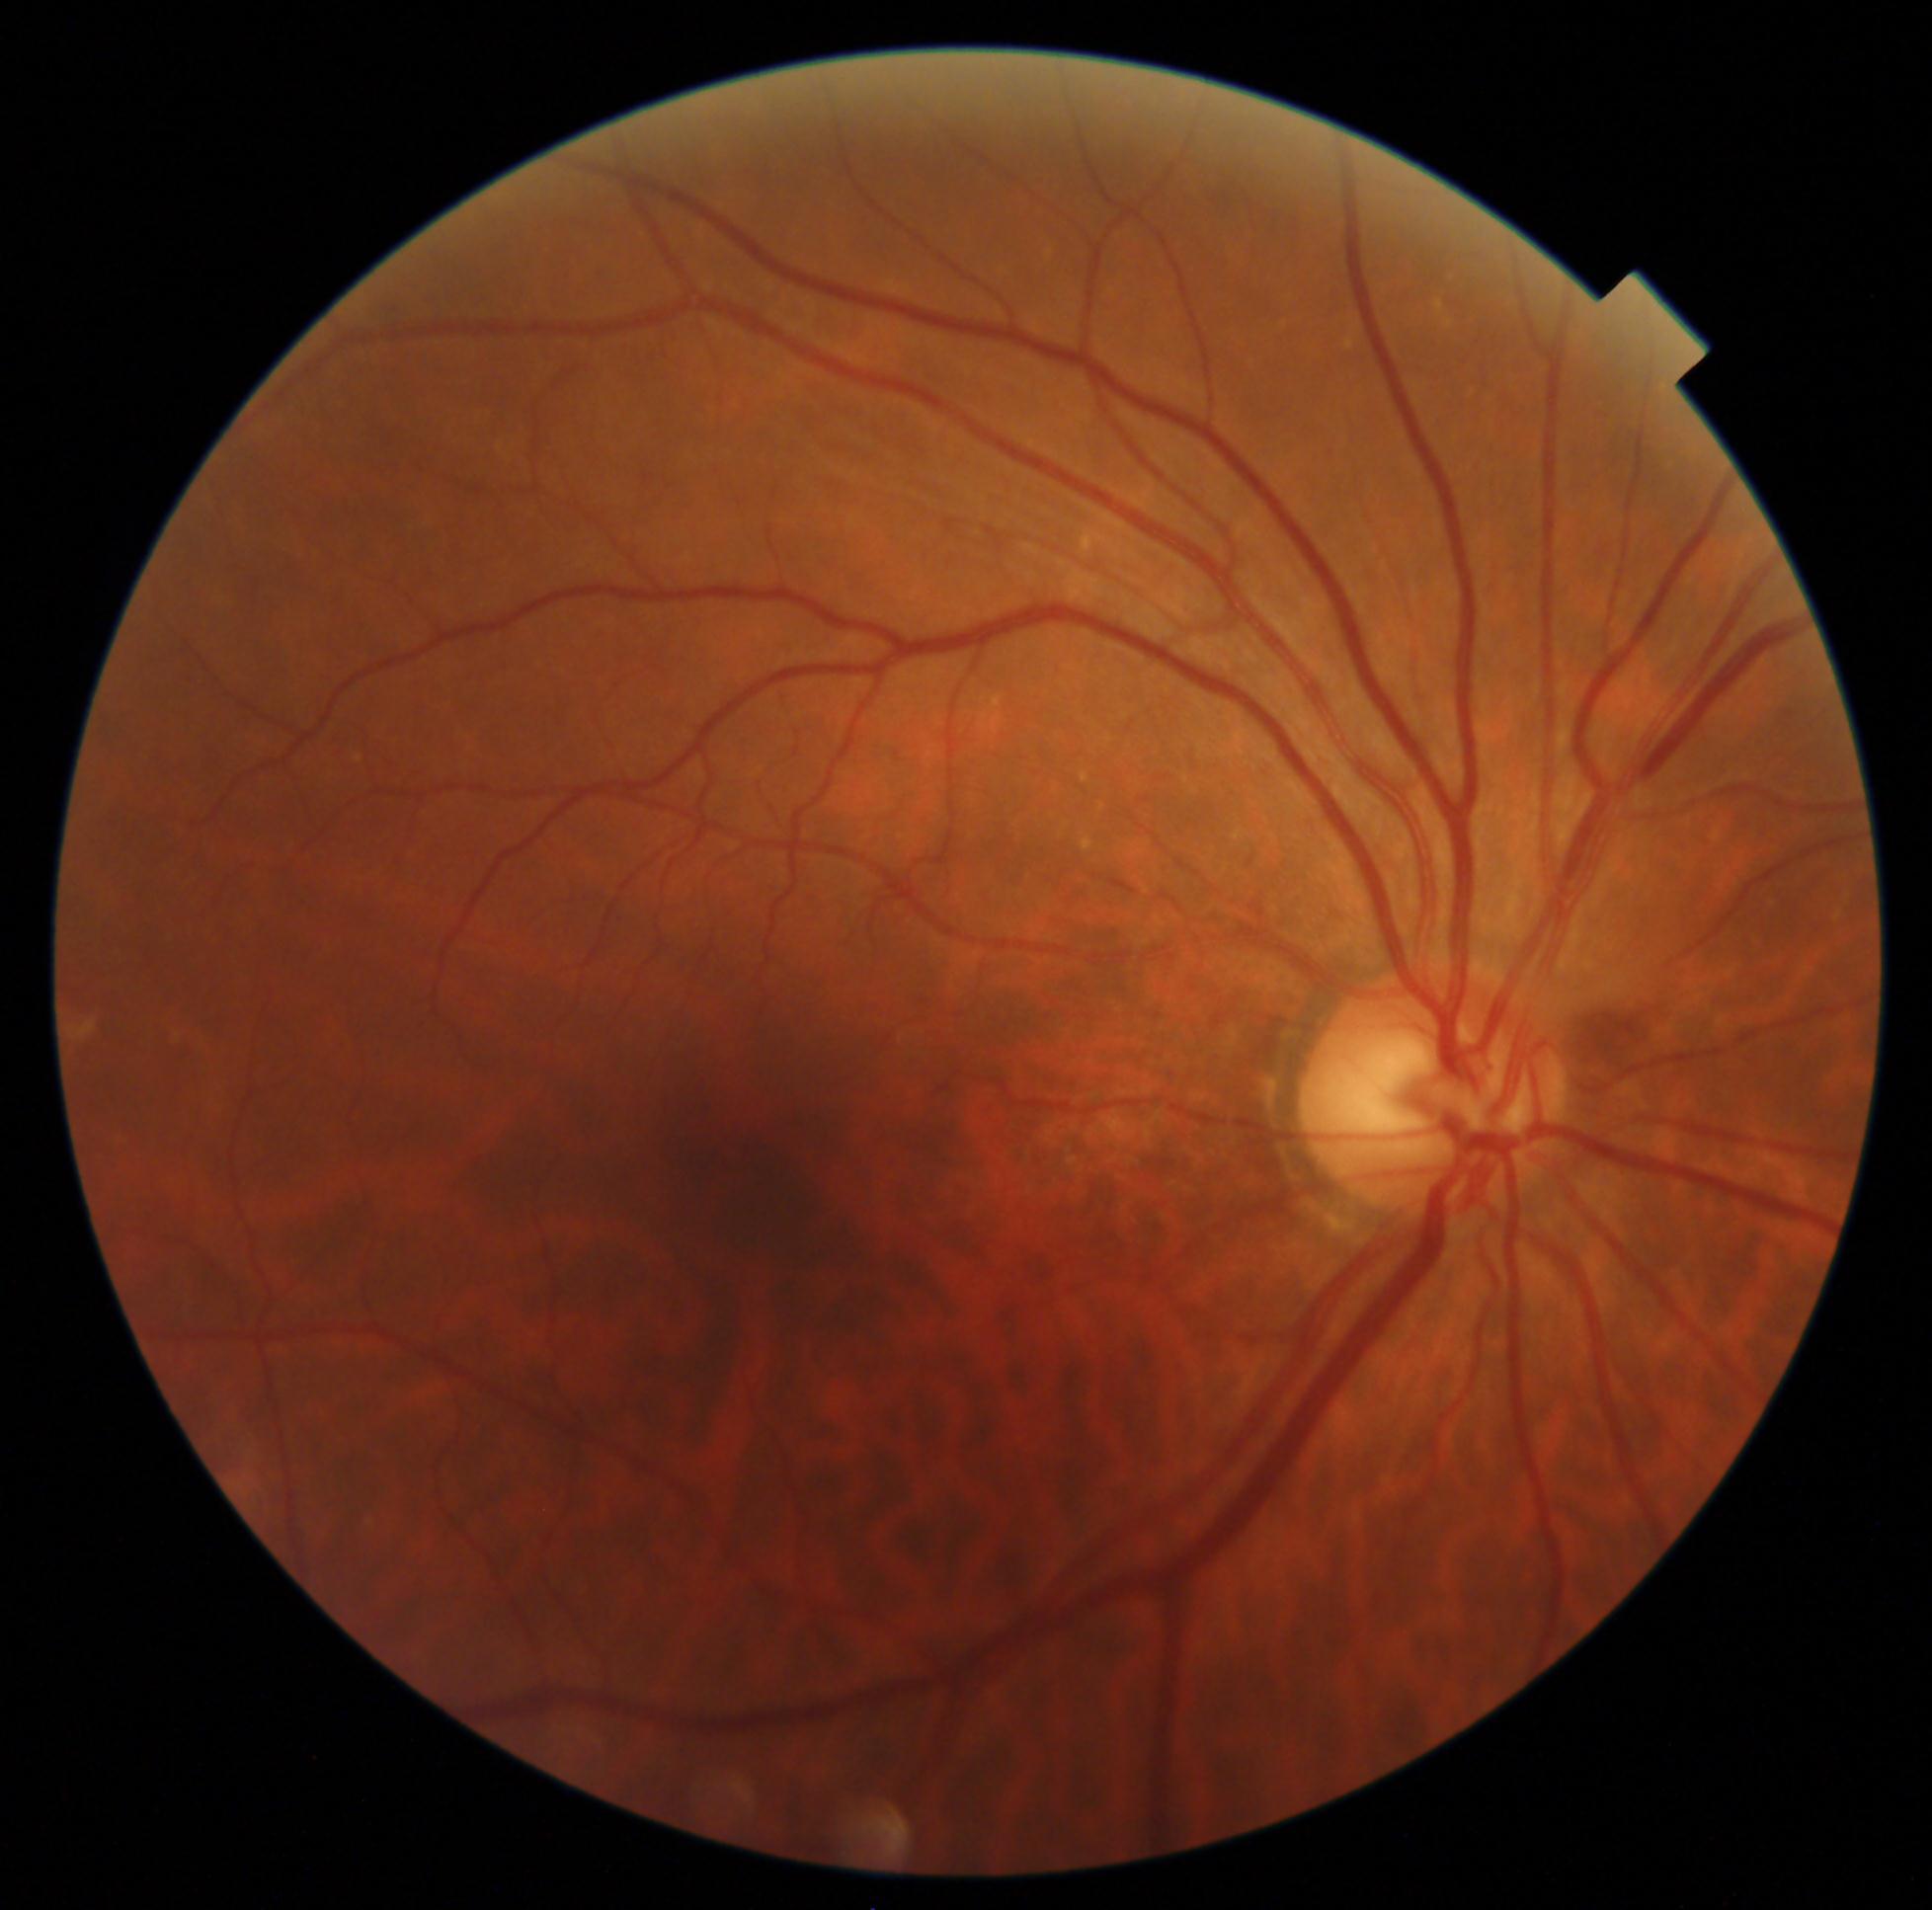

No apparent diabetic retinopathy.
Diabetic retinopathy: grade 0.